60° field of view. Fundus photo taken with a portable handheld camera:
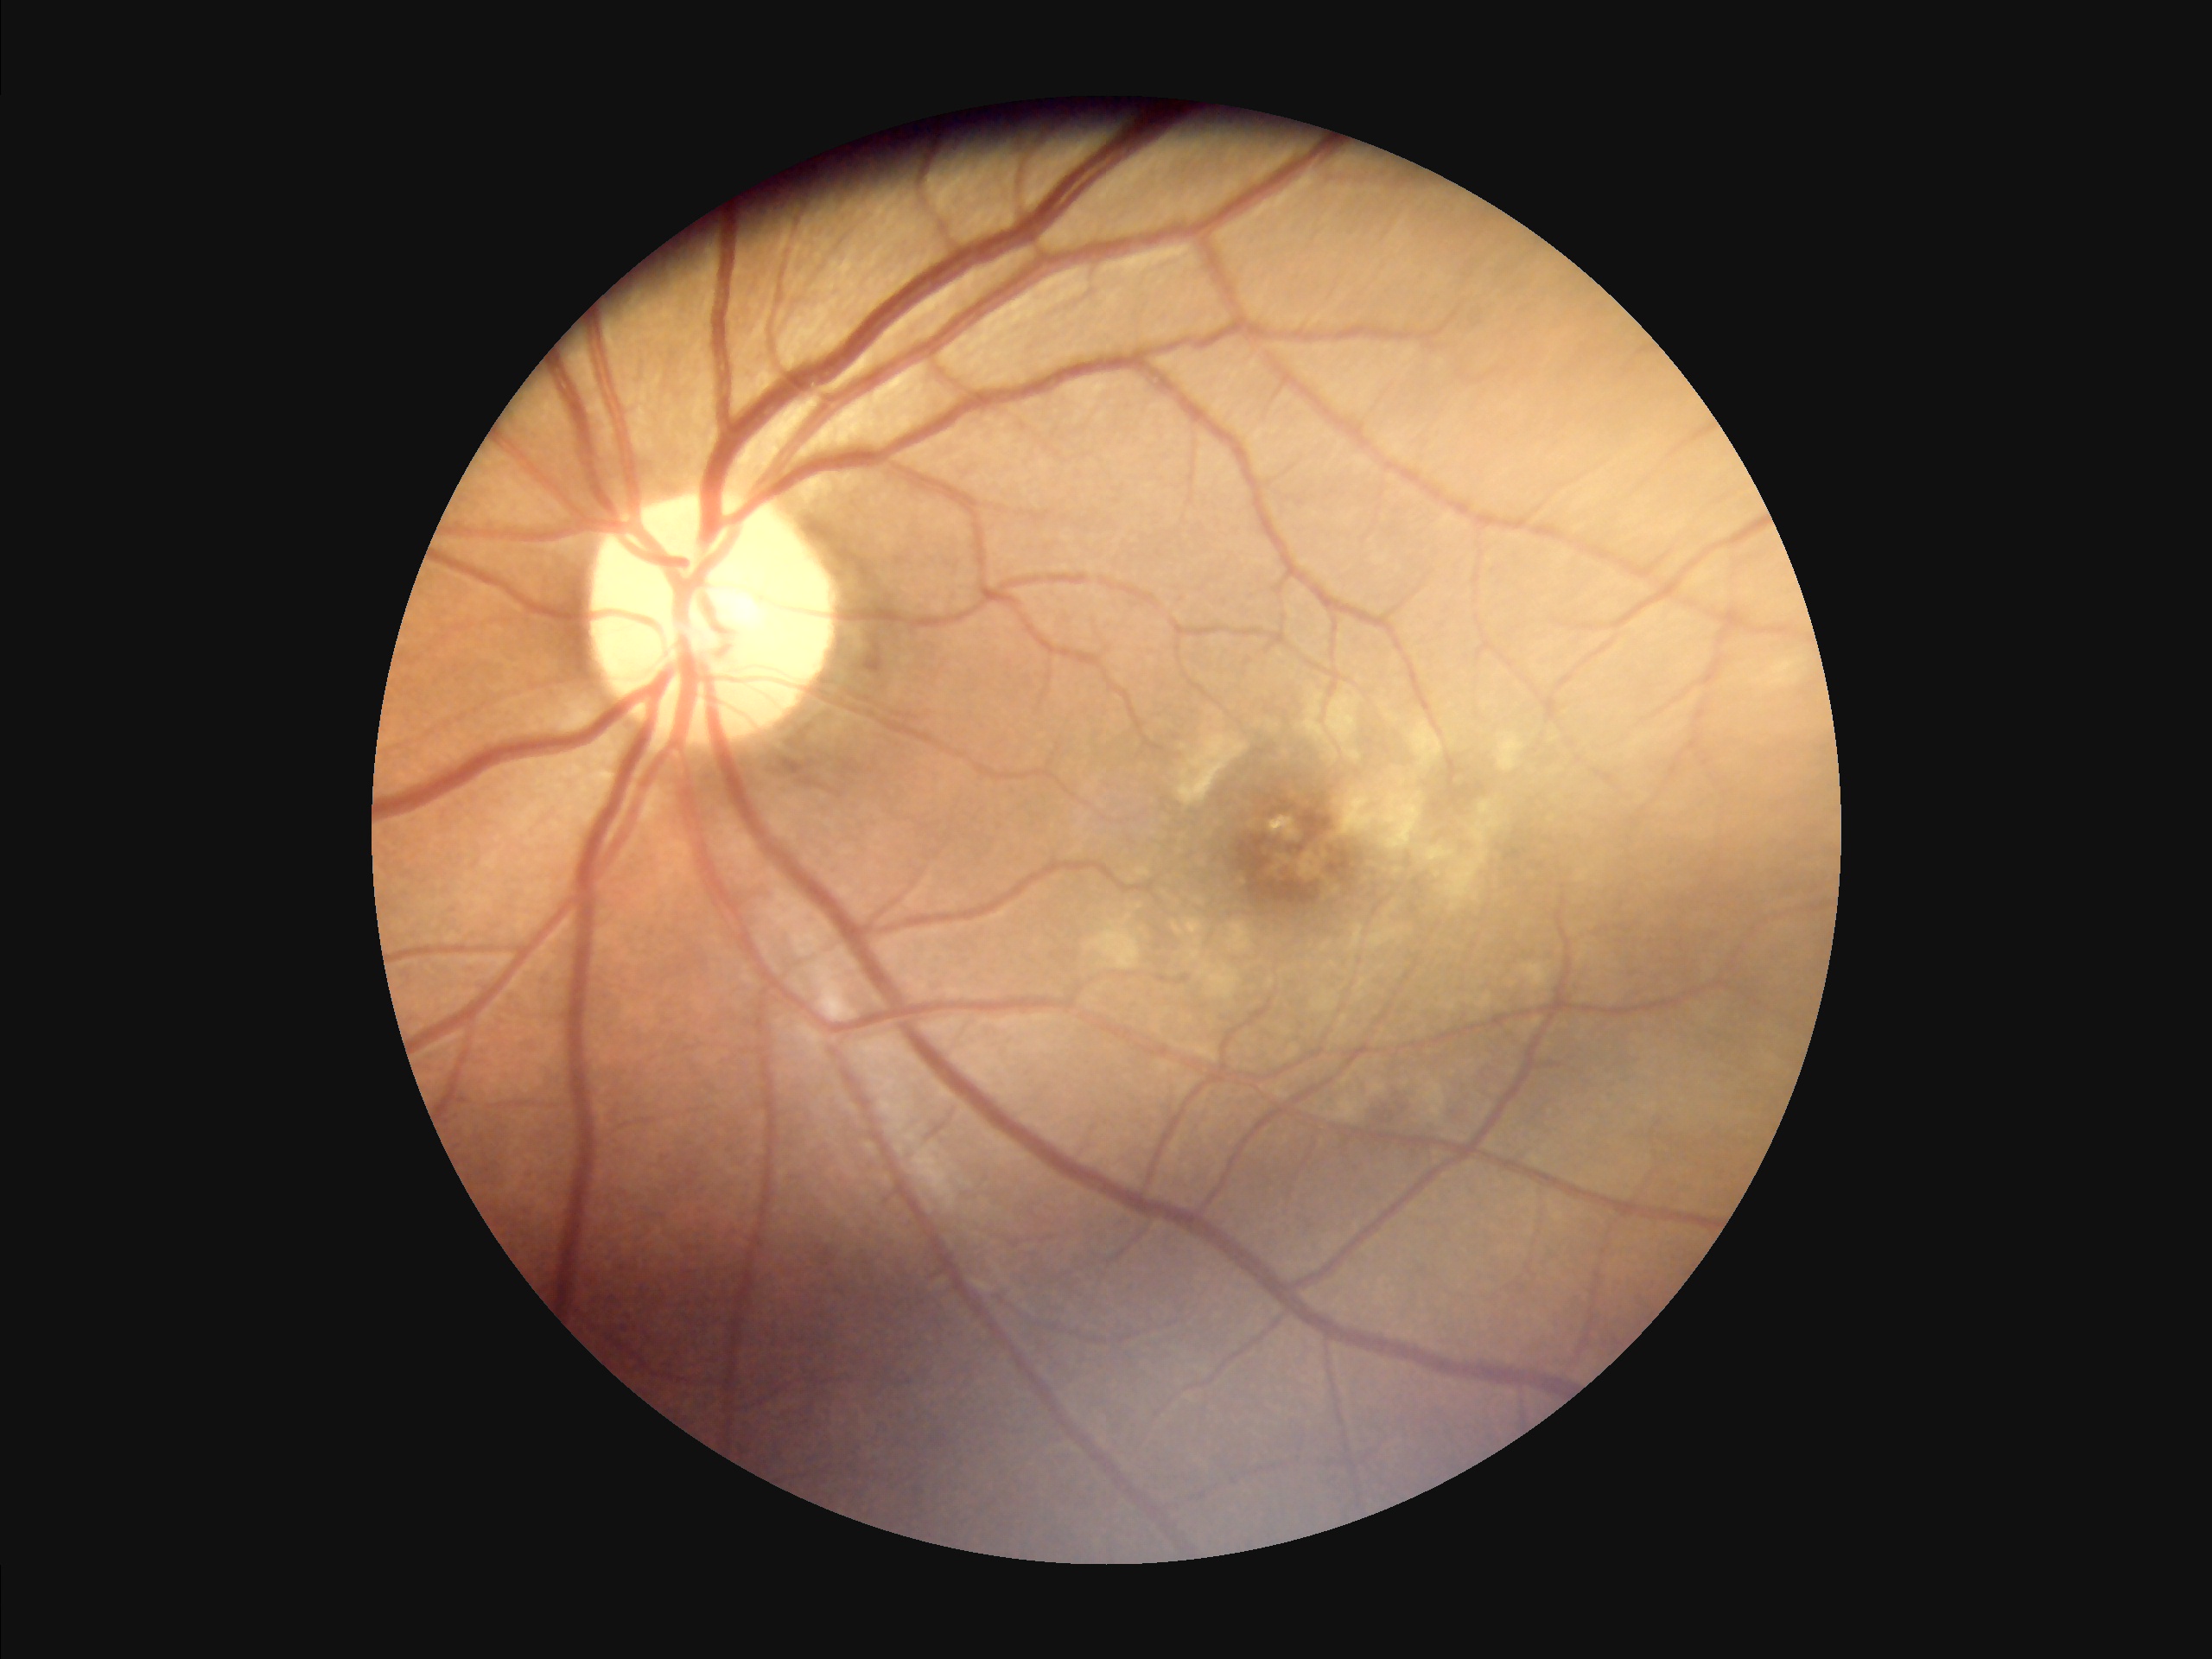
The image is clear. There is over- or under-exposure or a color cast. Good dynamic range.